Image size 1380x1382 — 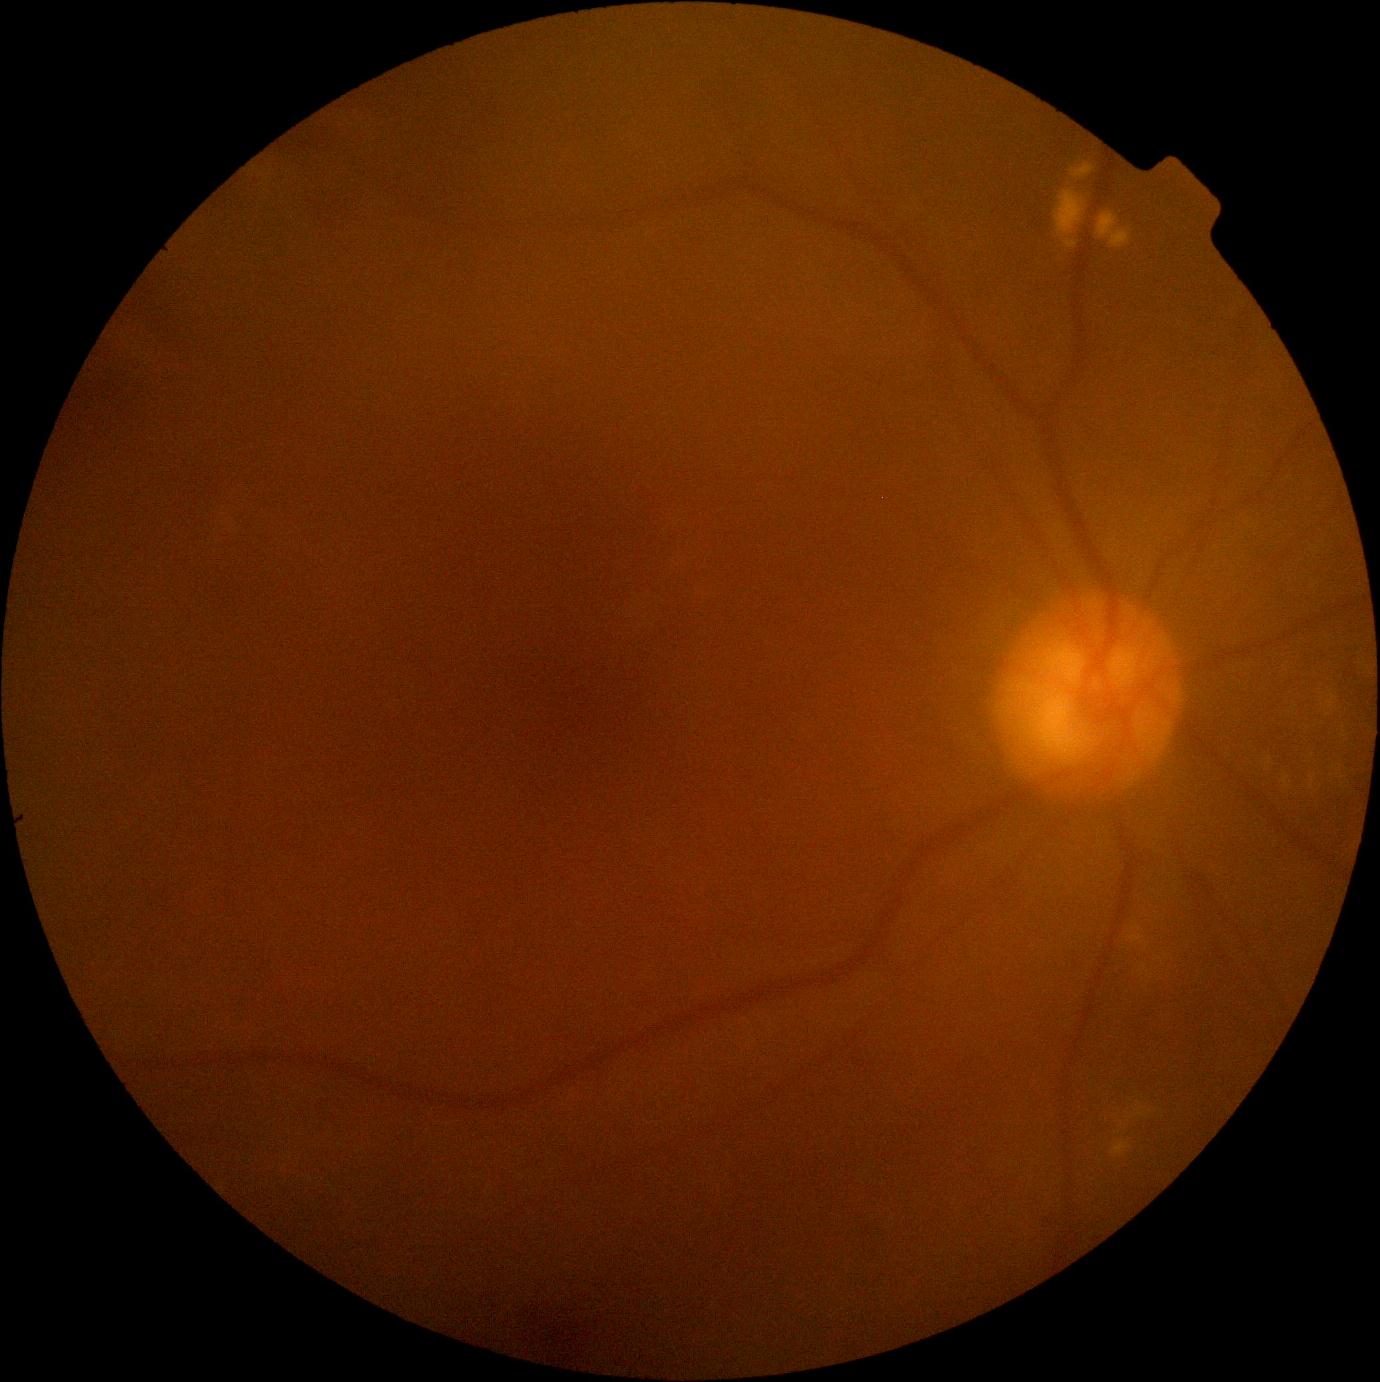
No signs of diabetic retinopathy. DR is grade 0 (no apparent retinopathy).